Fundus photo. Graded on the modified Davis scale. Nonmydriatic
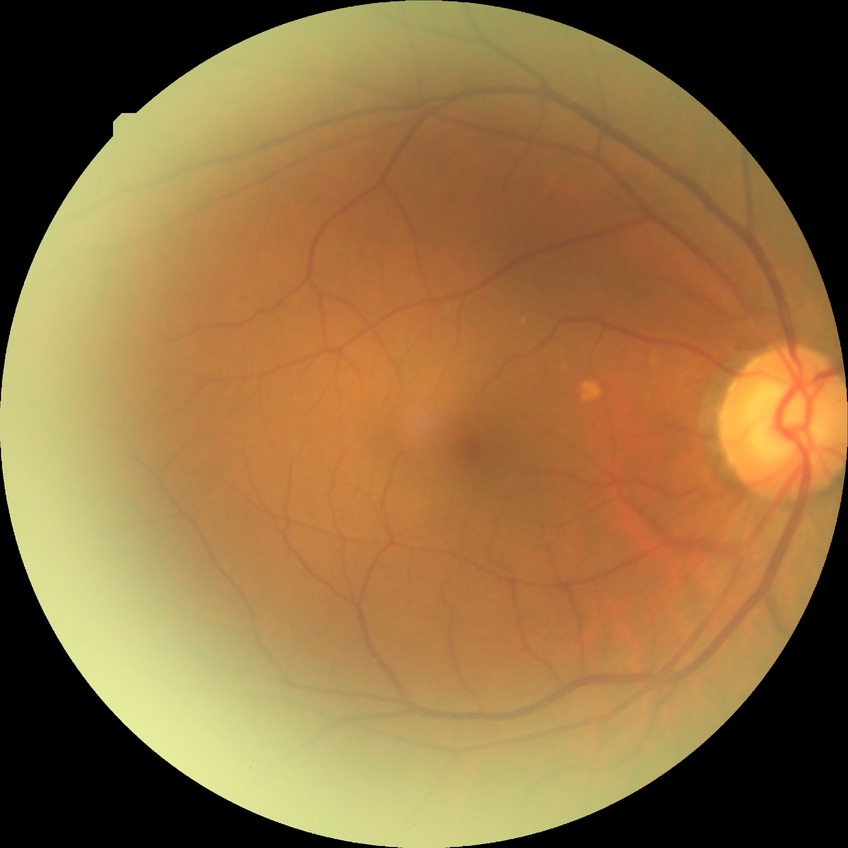

Retinopathy stage: no diabetic retinopathy.